Davis DR grading; 848x848
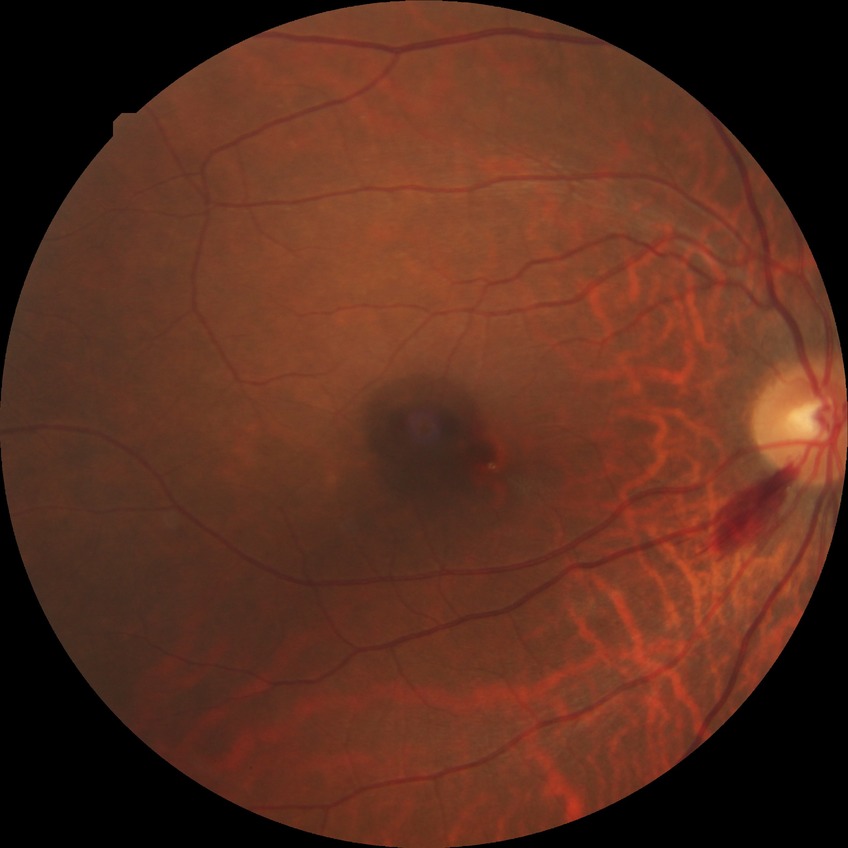
diabetic retinopathy (DR): no diabetic retinopathy (NDR).